2212 by 1659 pixels; 60° field of view; color fundus photograph from a handheld portable camera: 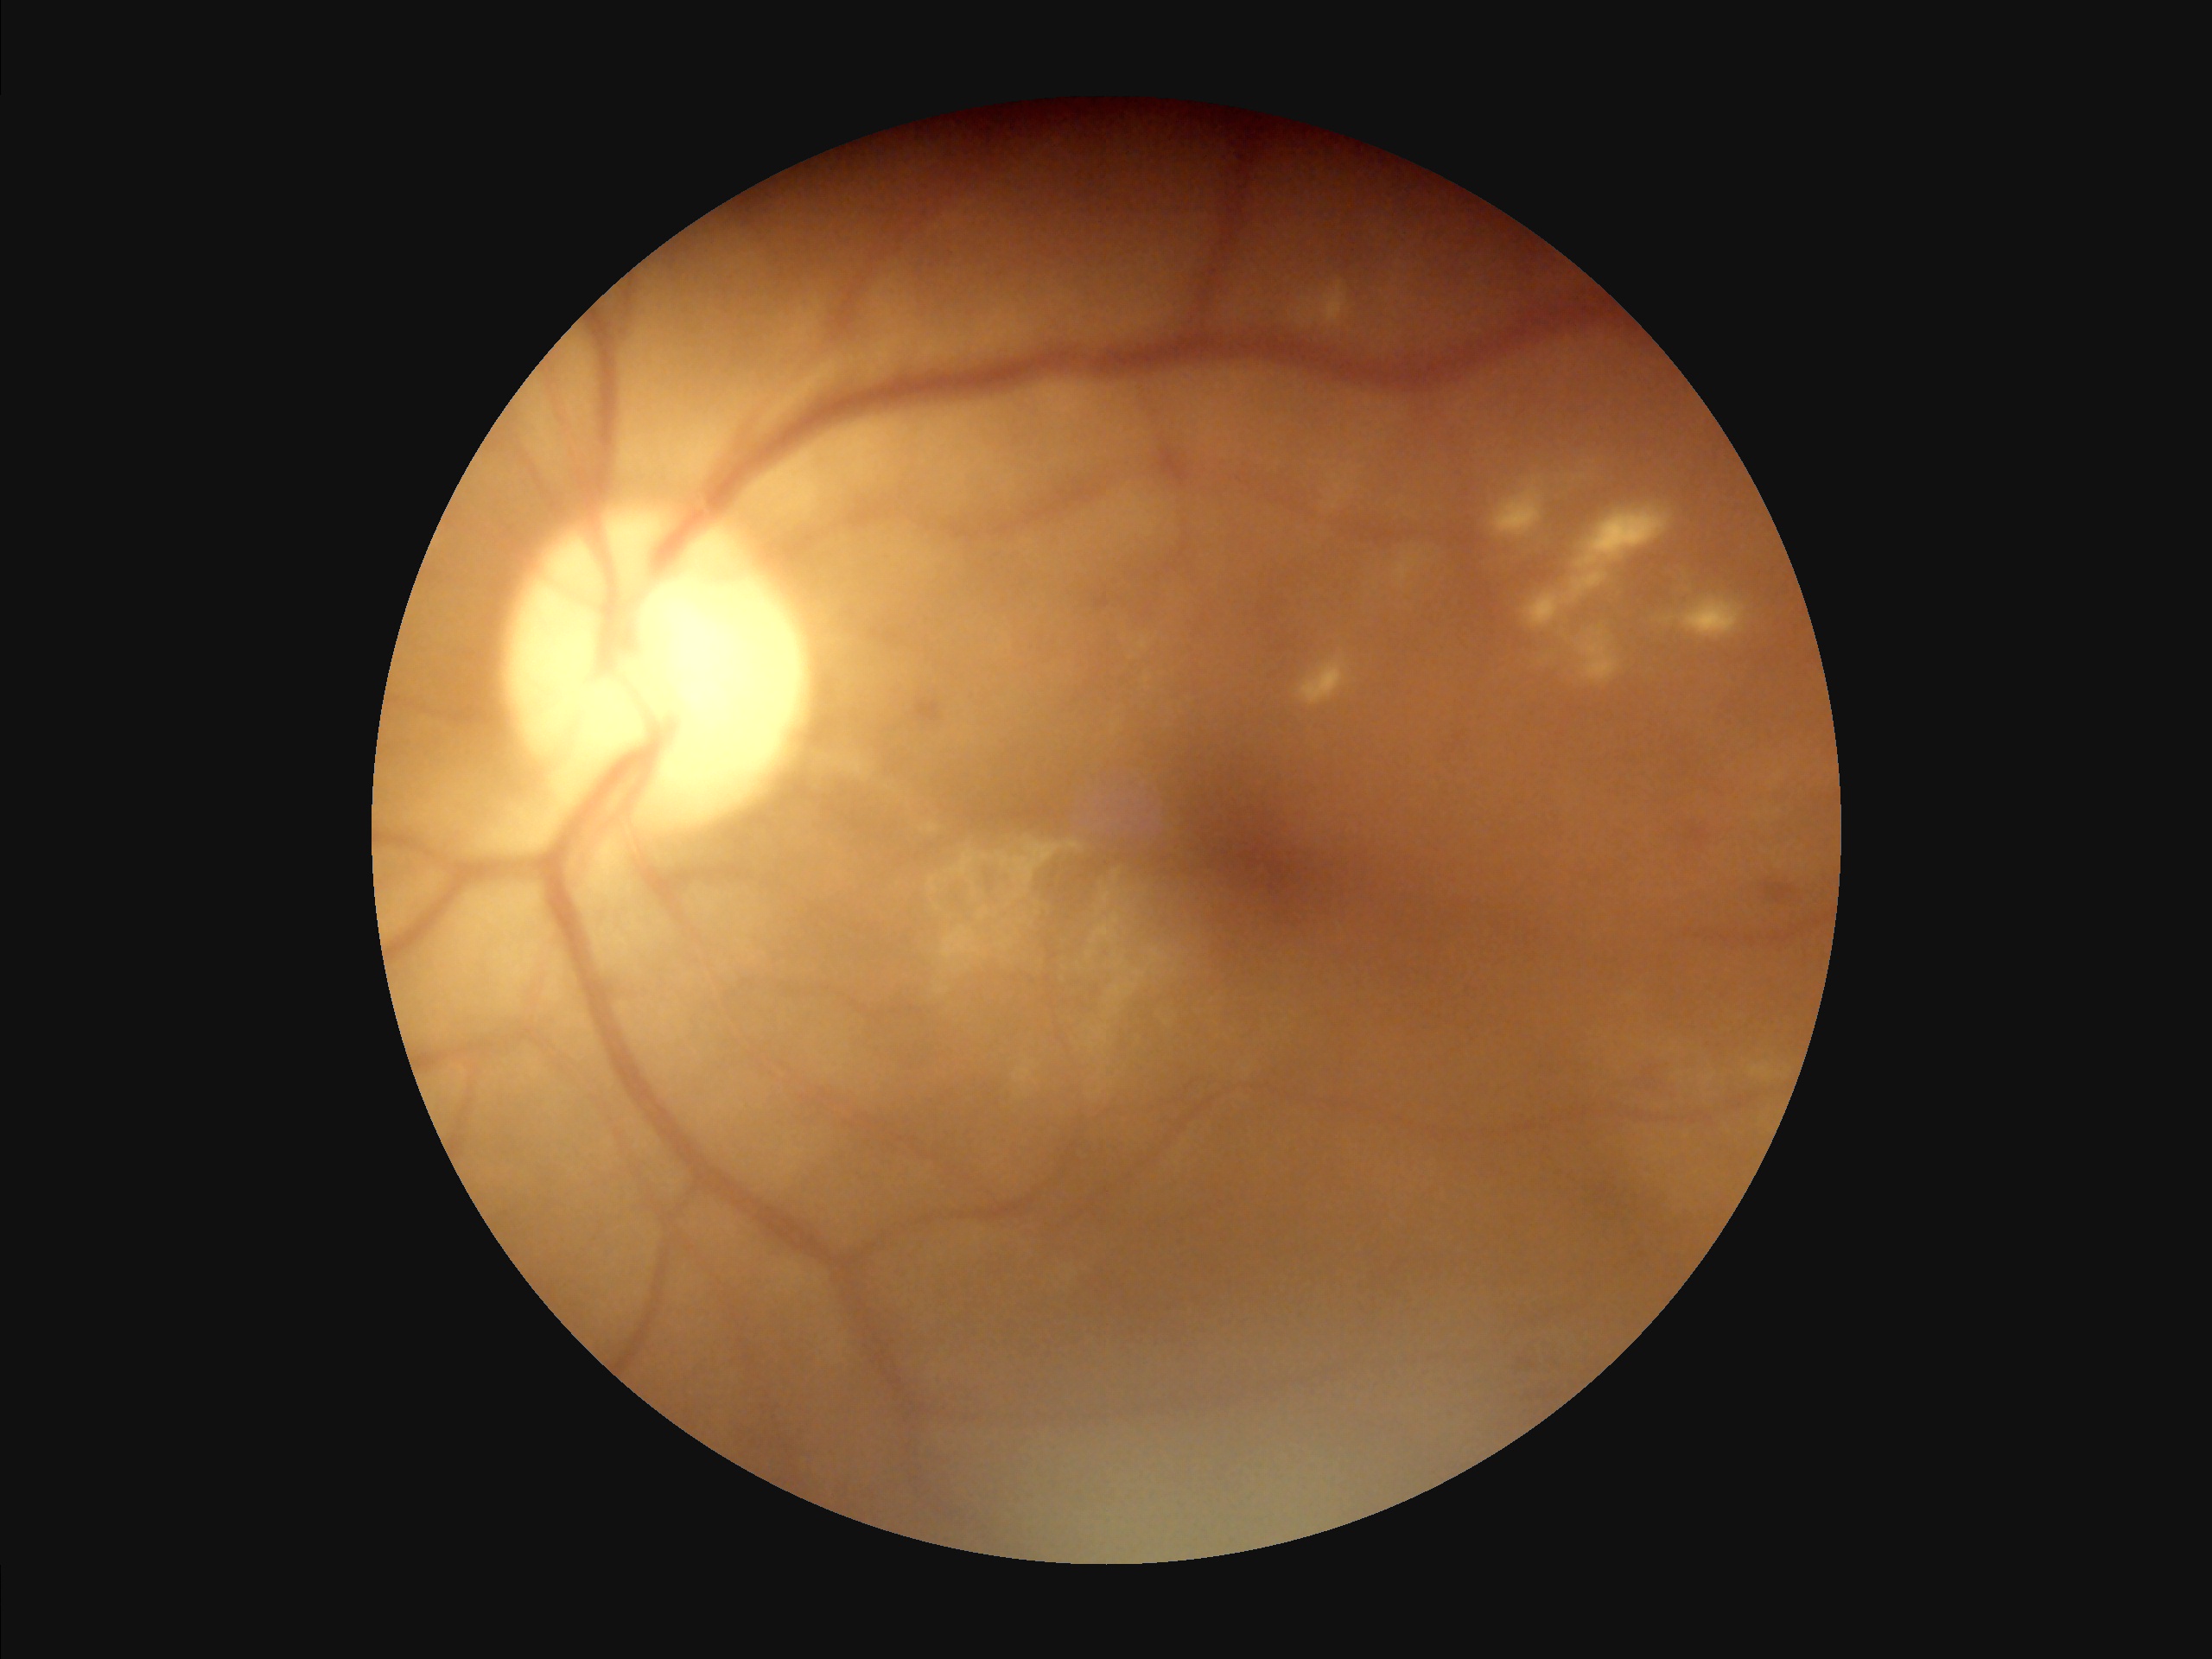 Image quality assessment:
- overall: inadequate for clinical interpretation
- contrast: good dynamic range
- sharpness: optic disc, vessels, and background in focus